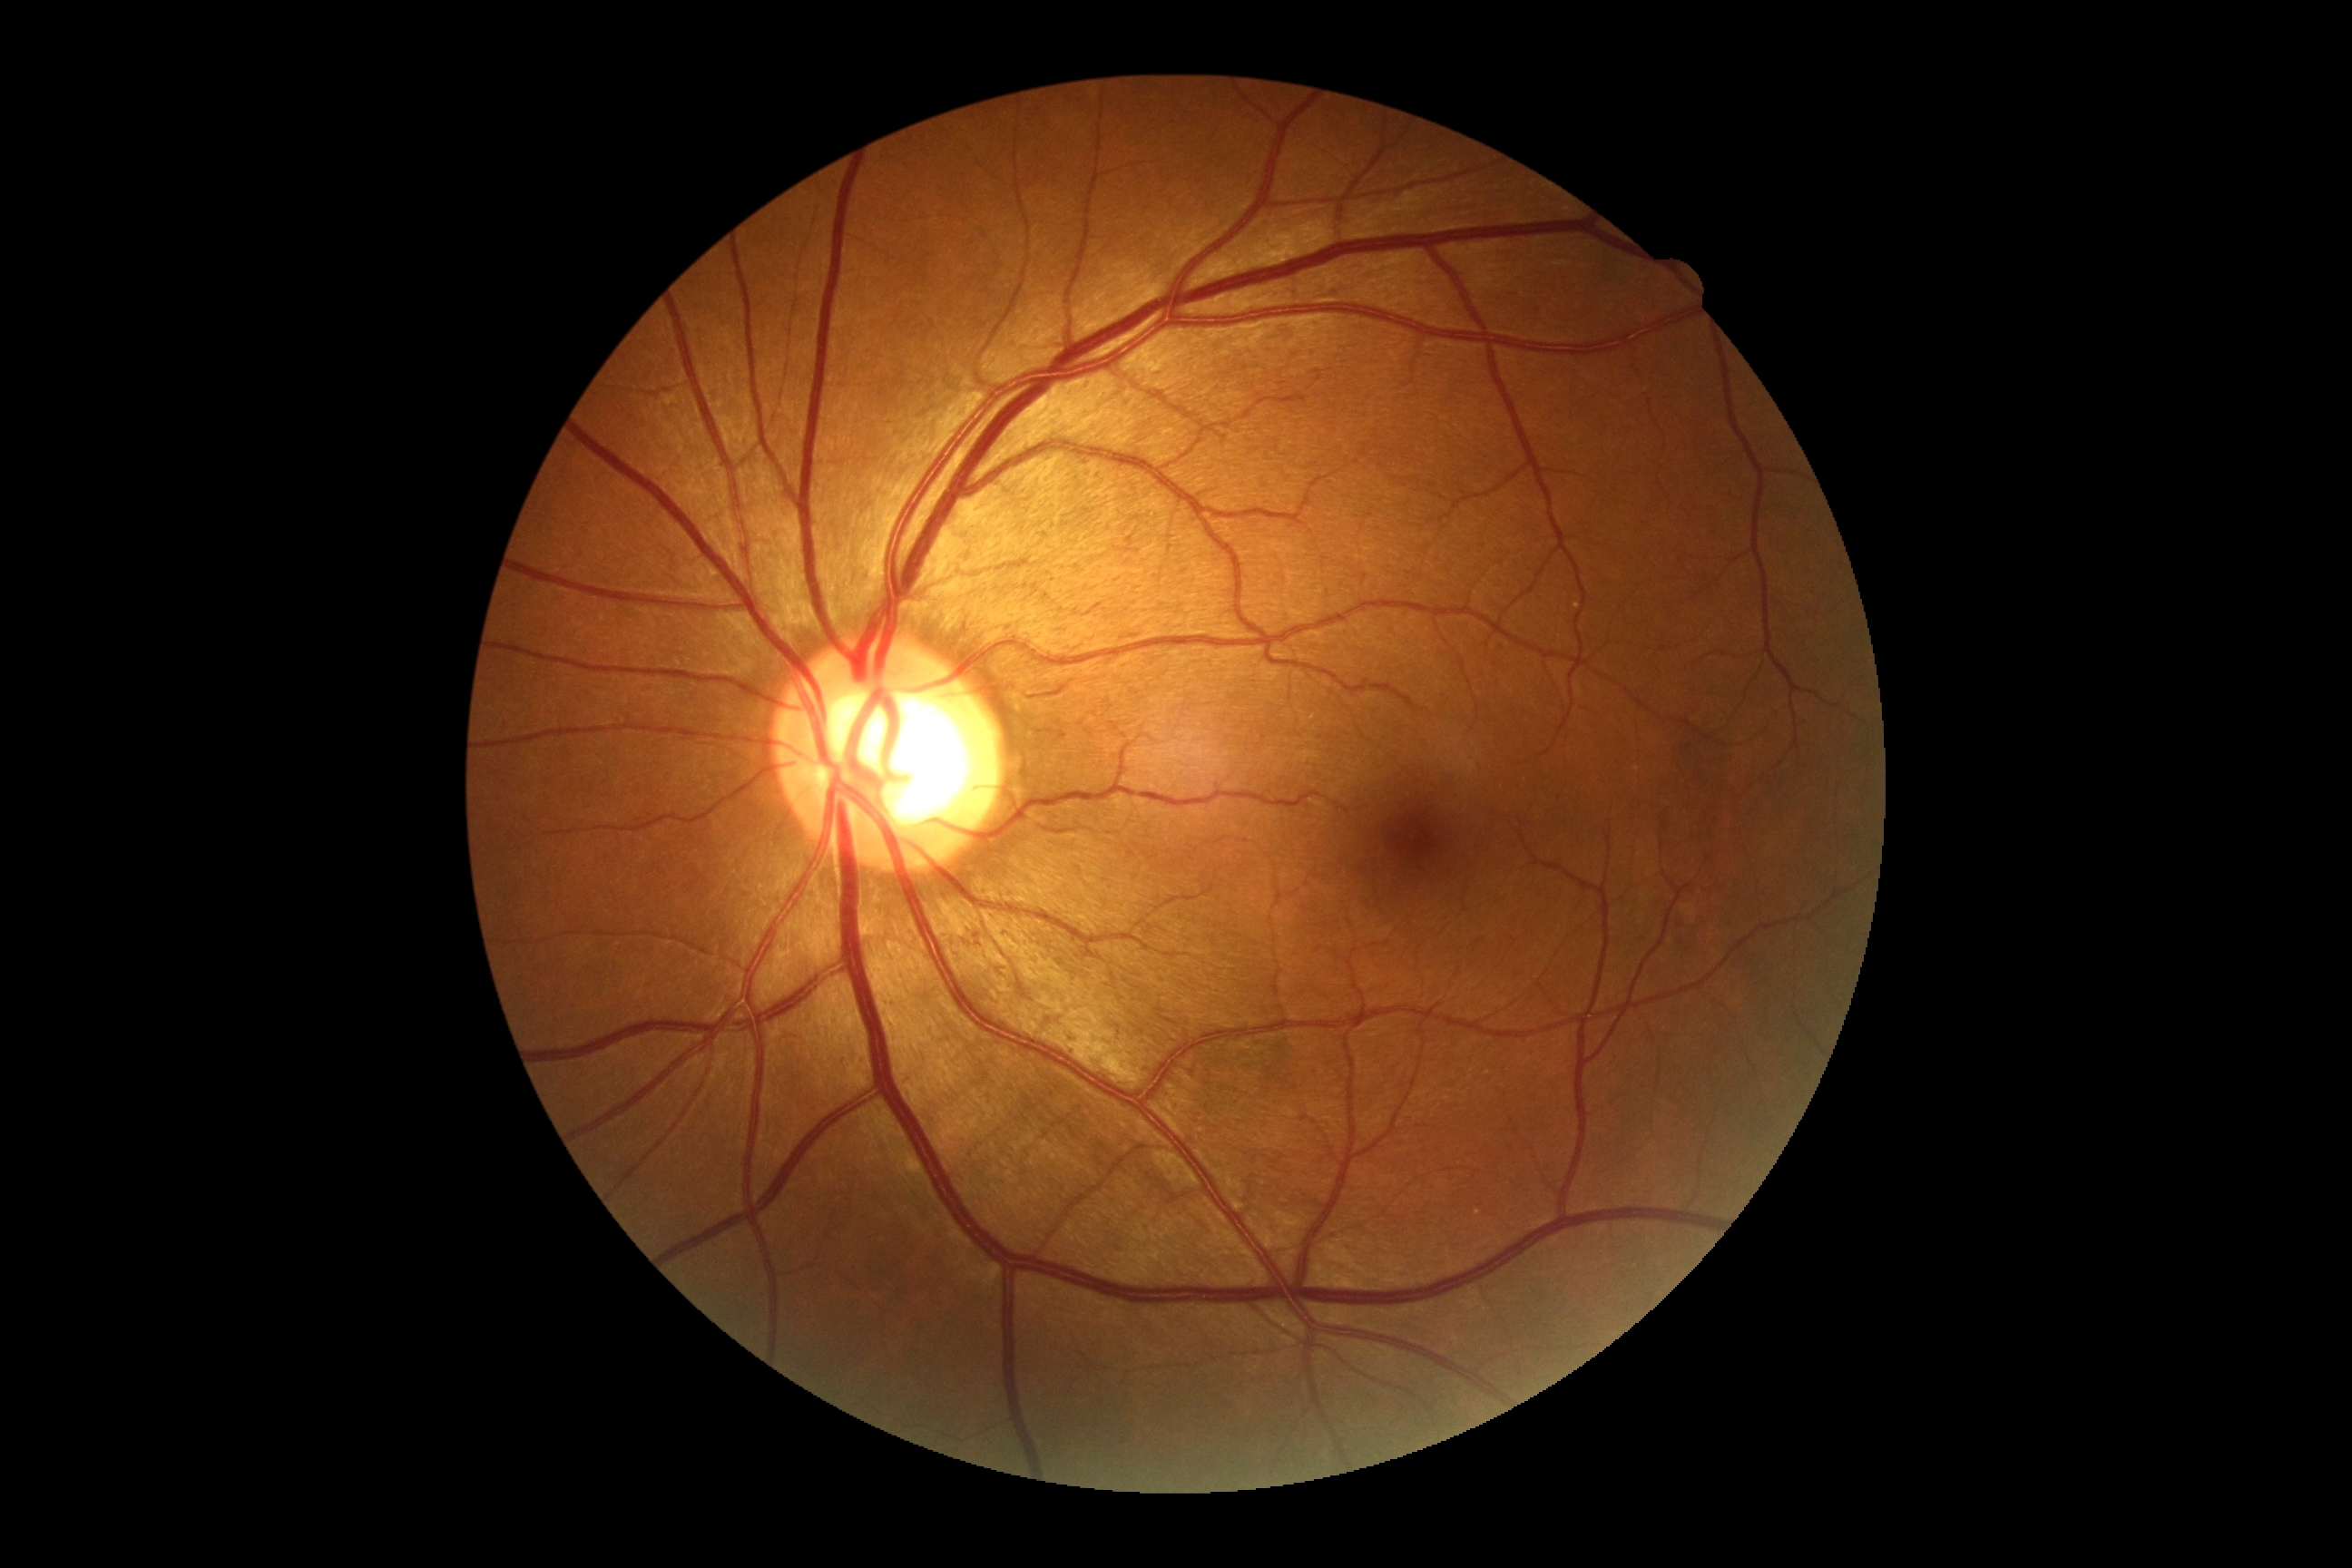 No apparent diabetic retinopathy. DR stage is grade 0 (no apparent retinopathy).